50° field of view. 2228x1652. Captured on a Topcon TRC-50DX fundus camera. Pupil-dilated. Posterior pole field covering the optic disc and macula: 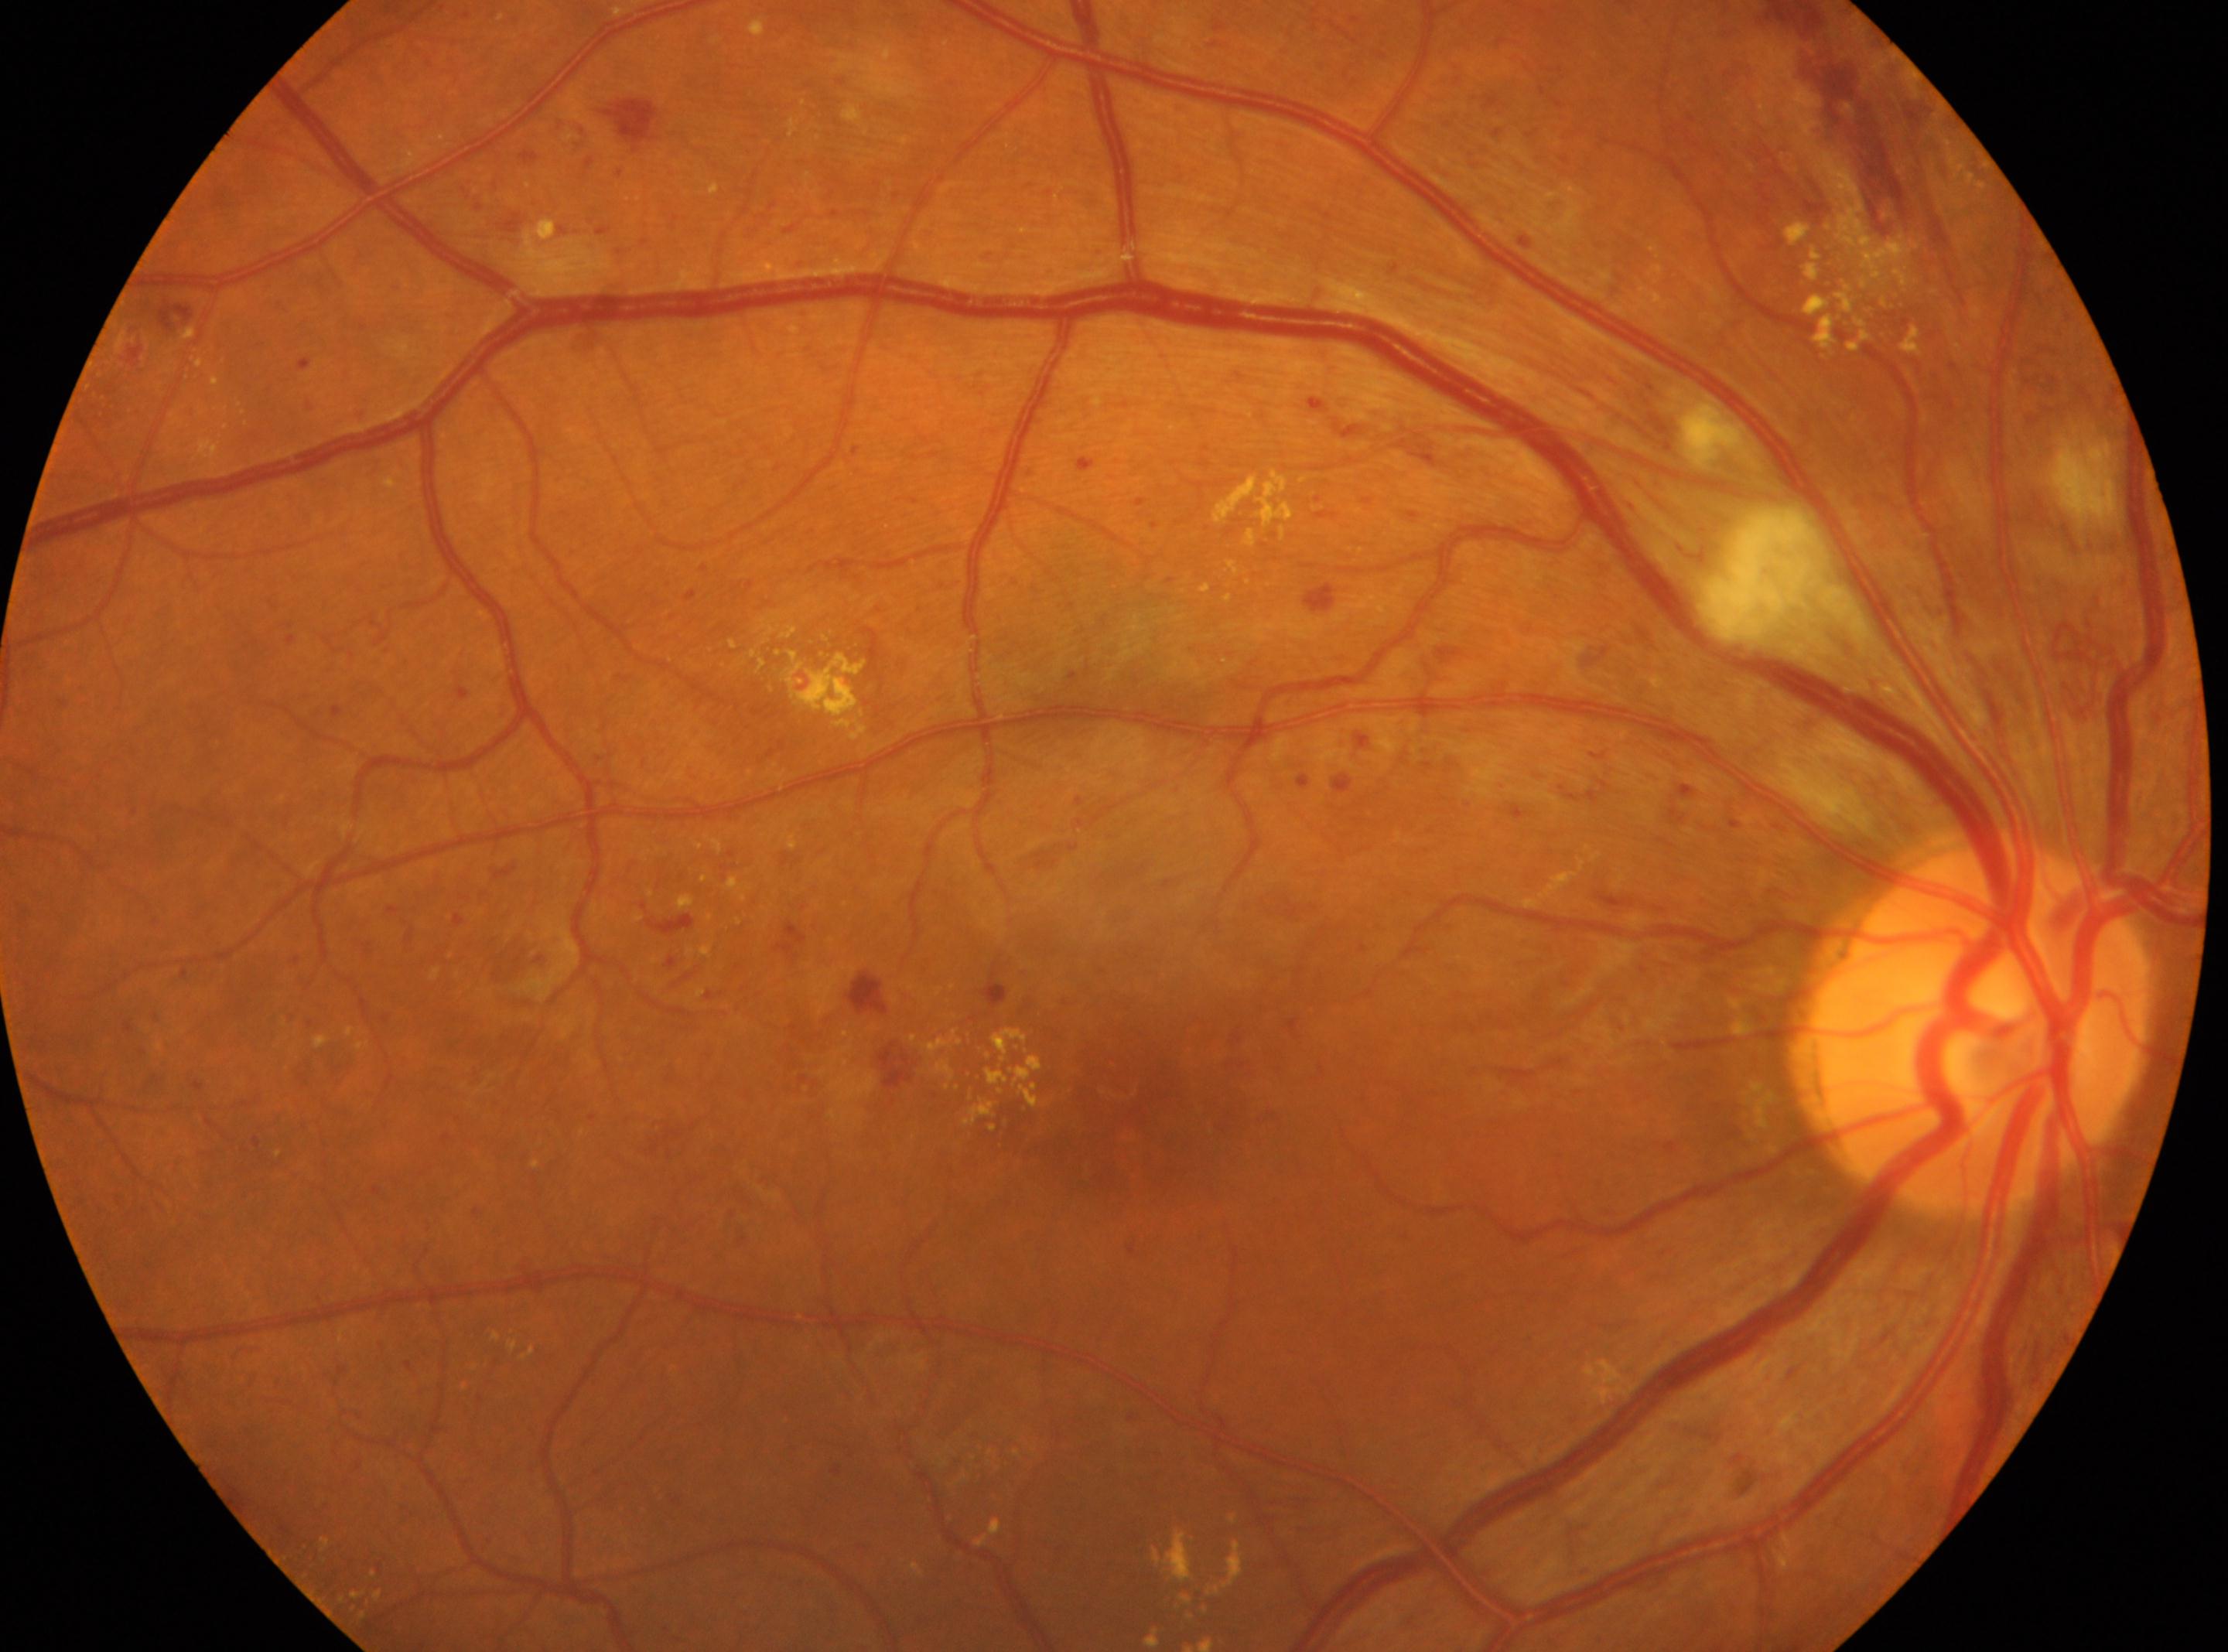 Disc center located at (x: 1979, y: 1027).
This is the right eye.
DR severity: severe non-proliferative diabetic retinopathy (grade 3) — more than 20 intraretinal hemorrhages in each of 4 quadrants, definite venous beading in 2 or more quadrants, or prominent intraretinal microvascular abnormalities in 1 or more quadrants, with no signs of proliferative retinopathy.
The fovea is at (x: 1139, y: 1109).